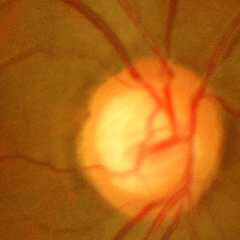 Glaucoma stage = no glaucomatous optic neuropathy.